Fundus photo; 2048 x 1536 pixels.
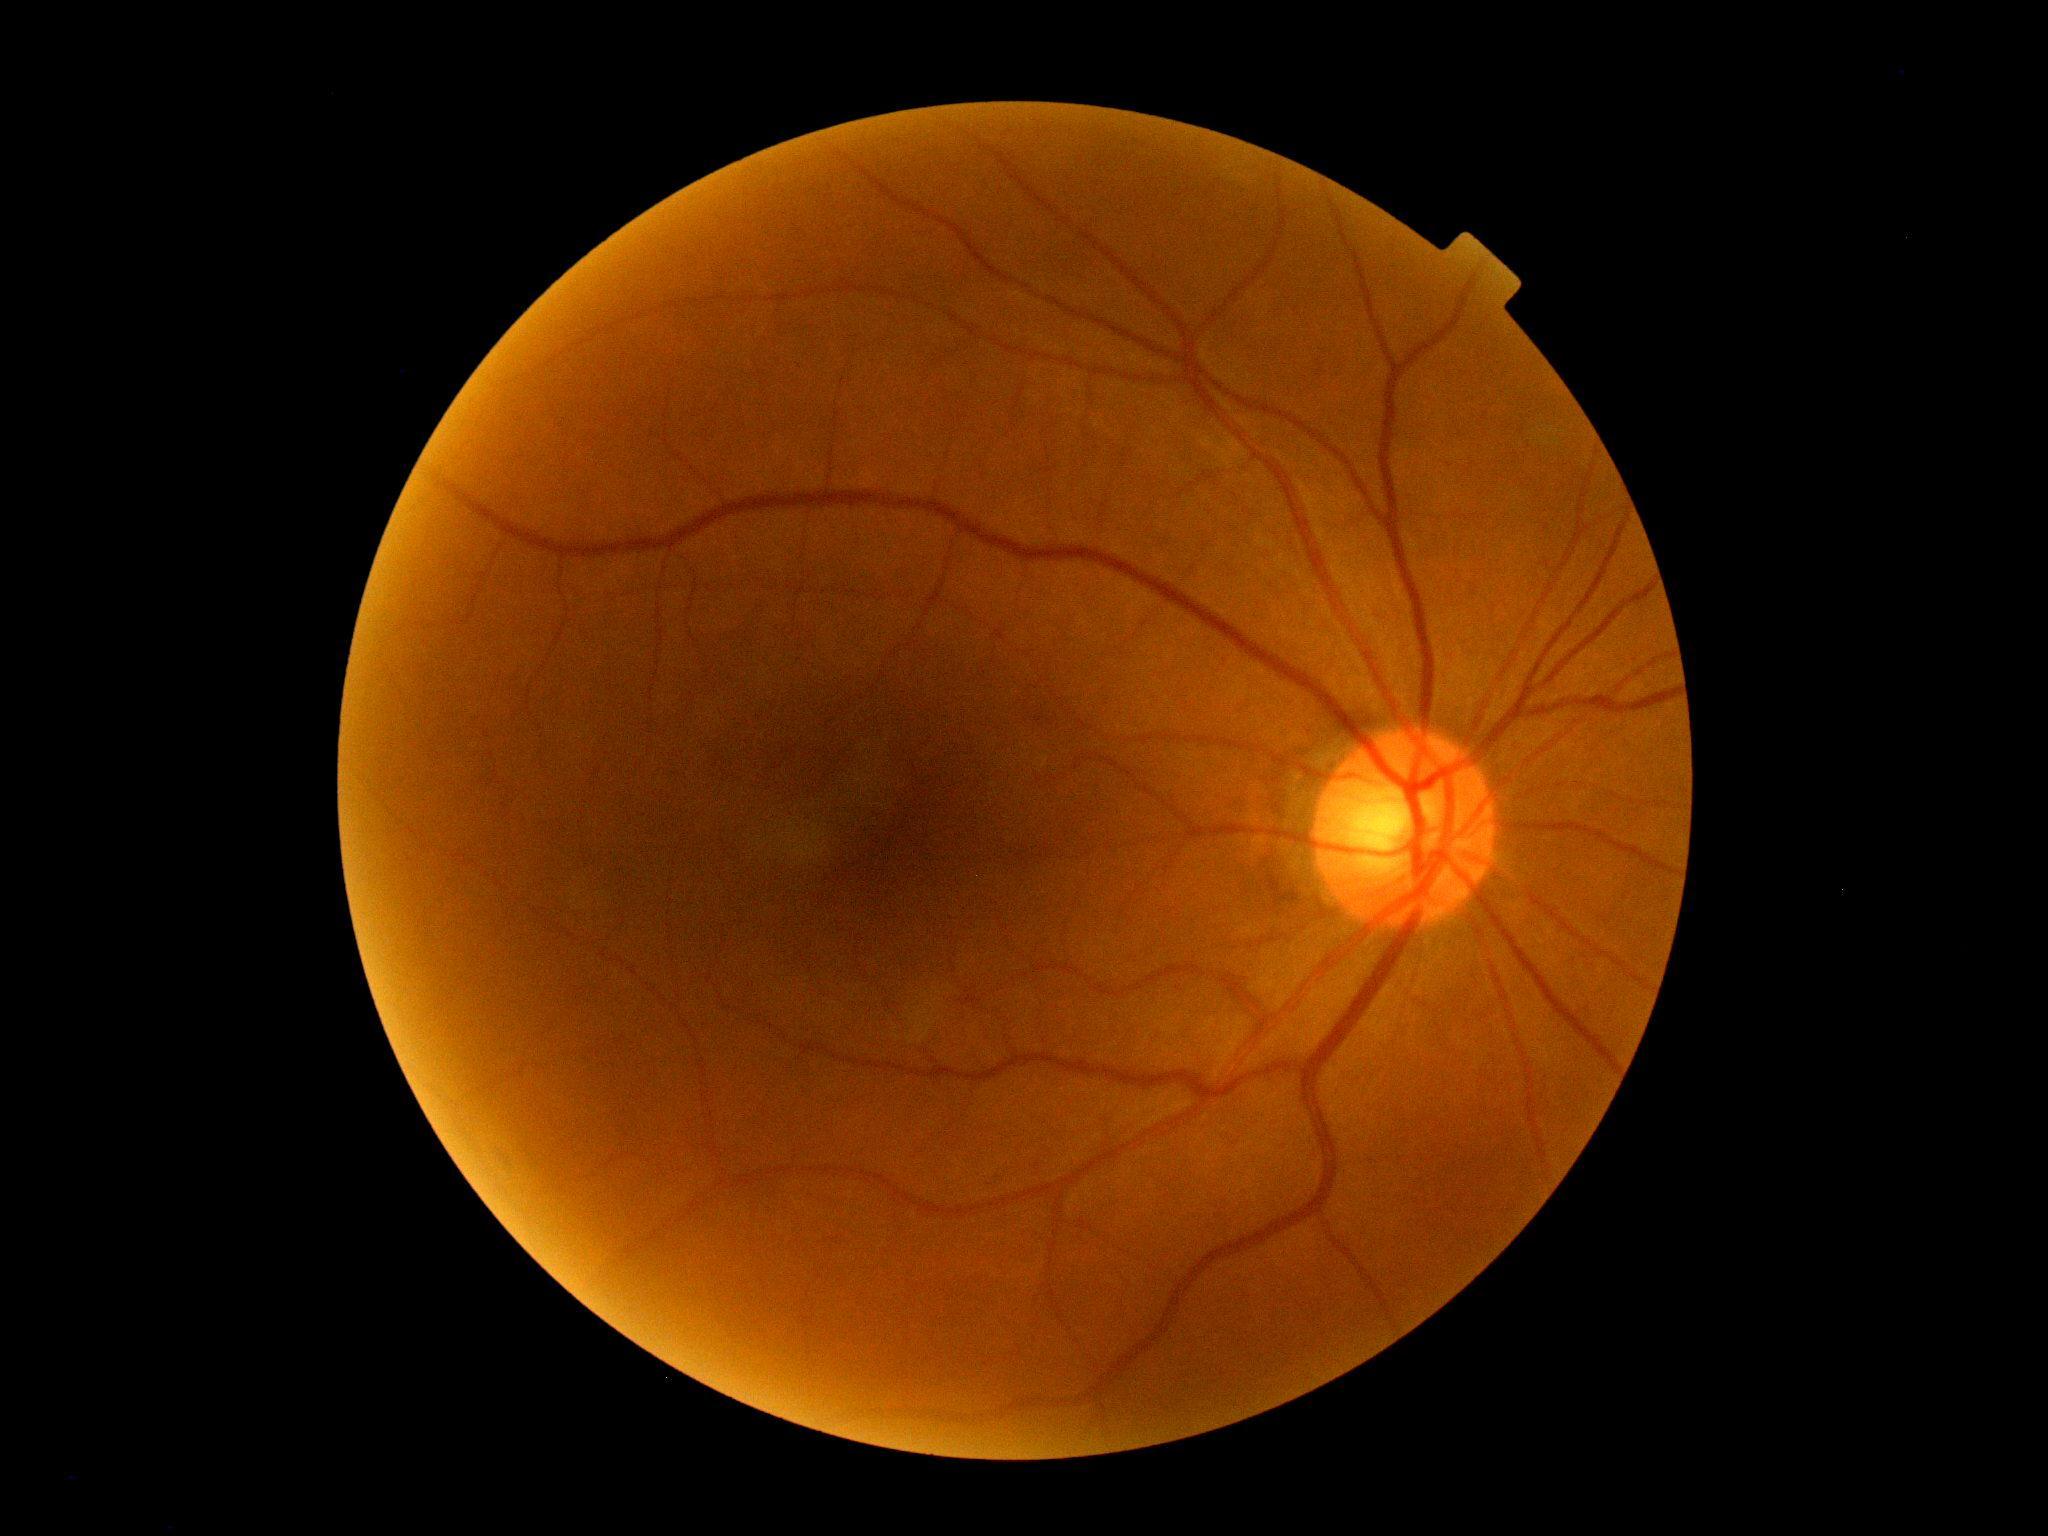
diabetic retinopathy (DR): no apparent retinopathy (grade 0).